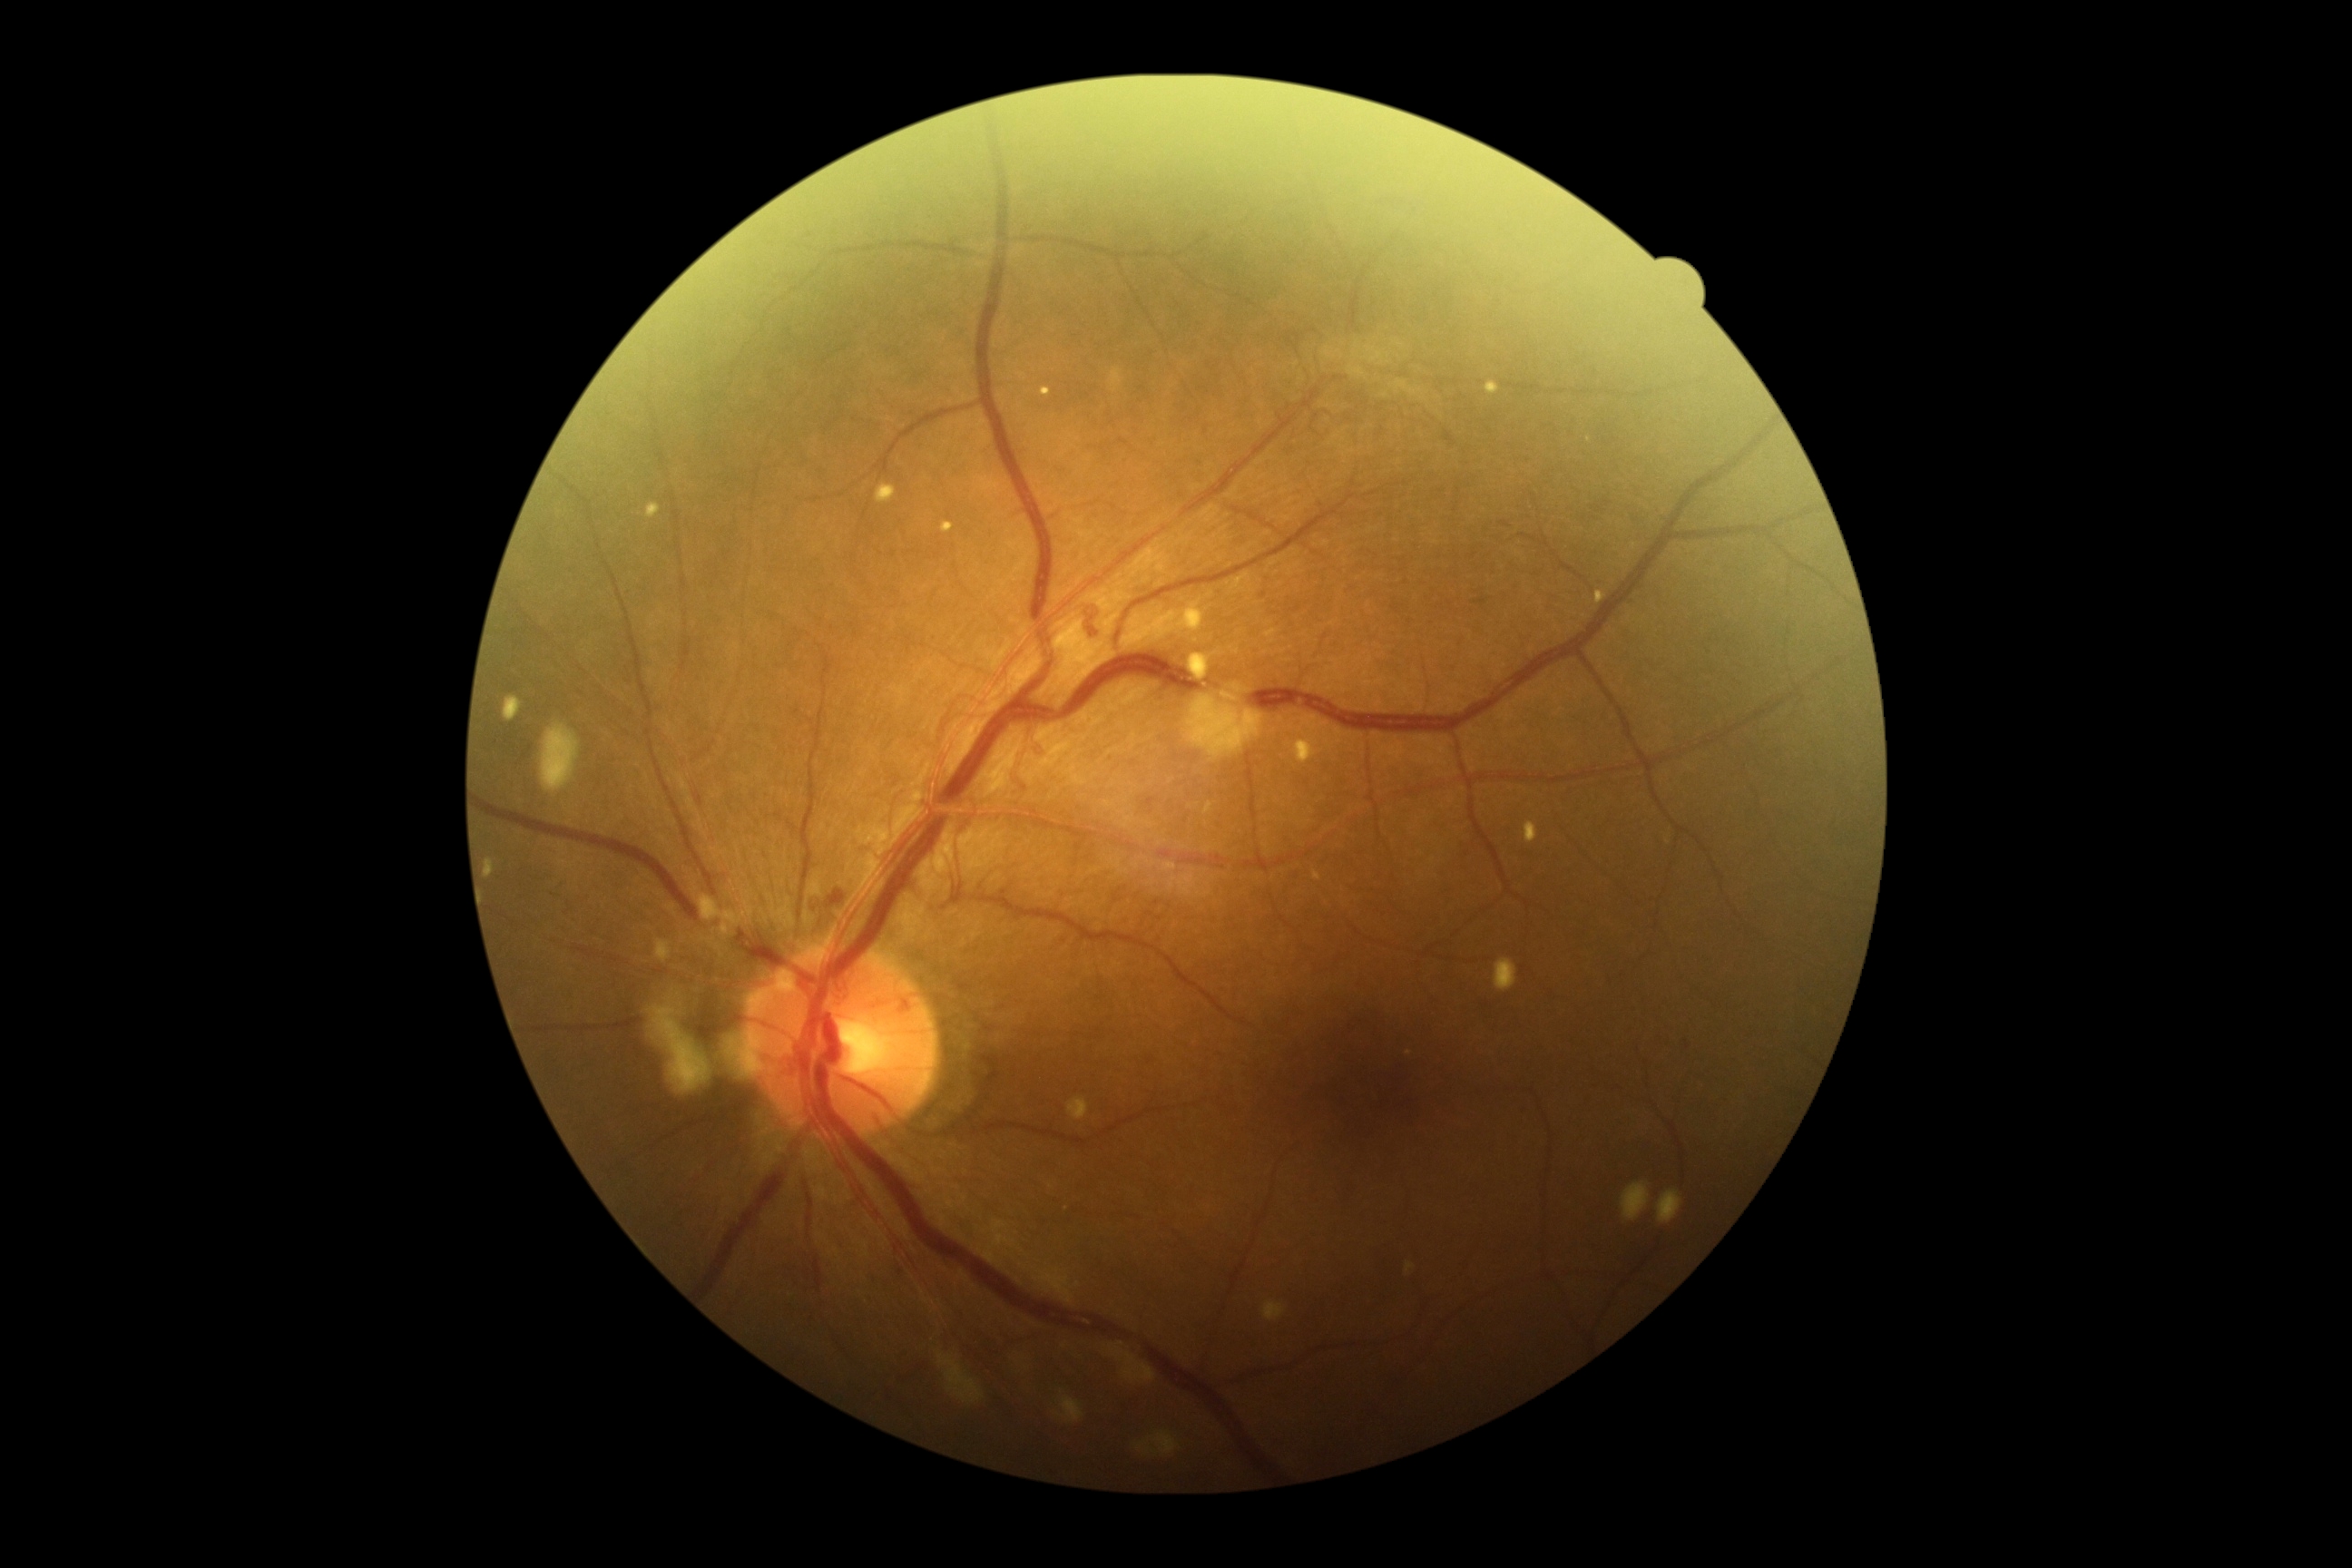
DR: PDR (grade 4).